Nonmydriatic; modified Davis grading; FOV: 45 degrees: 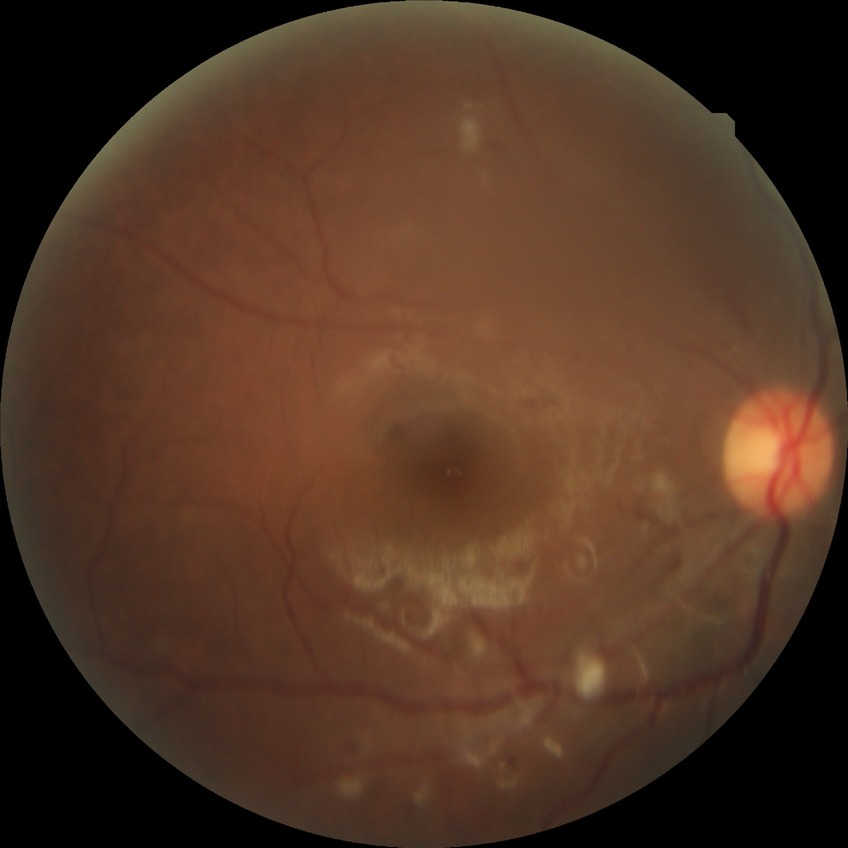 {
  "davis_grade": "pre-proliferative diabetic retinopathy"
}